848x848 · posterior pole color fundus photograph:
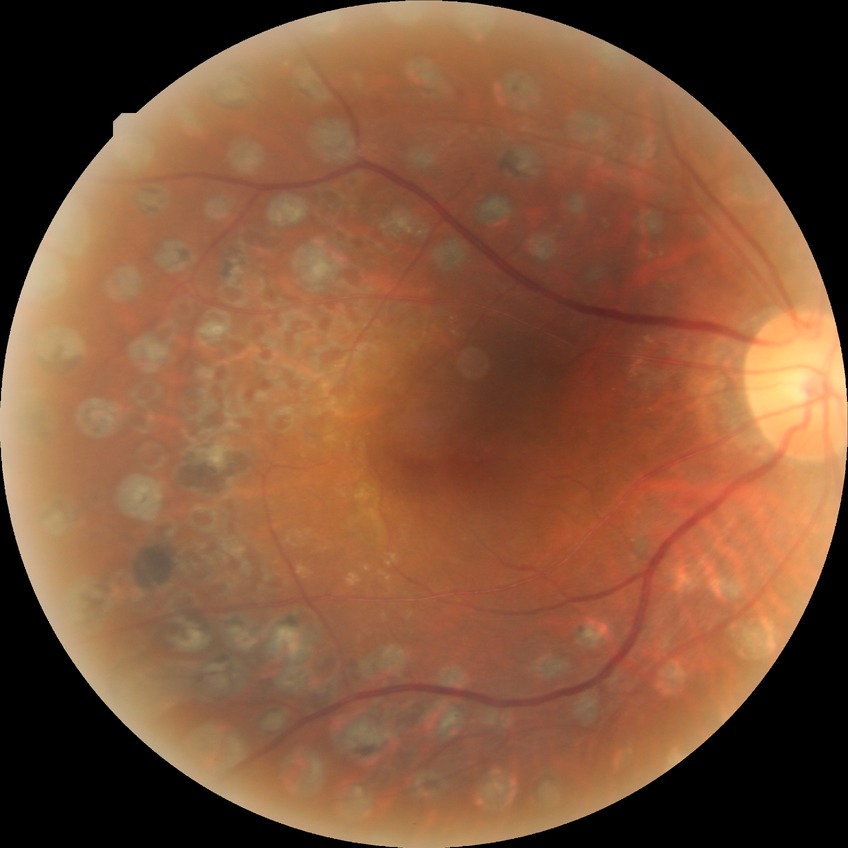

diabetic retinopathy (DR)=proliferative diabetic retinopathy (PDR).